Image size 848x848. Posterior pole color fundus photograph. NIDEK AFC-230
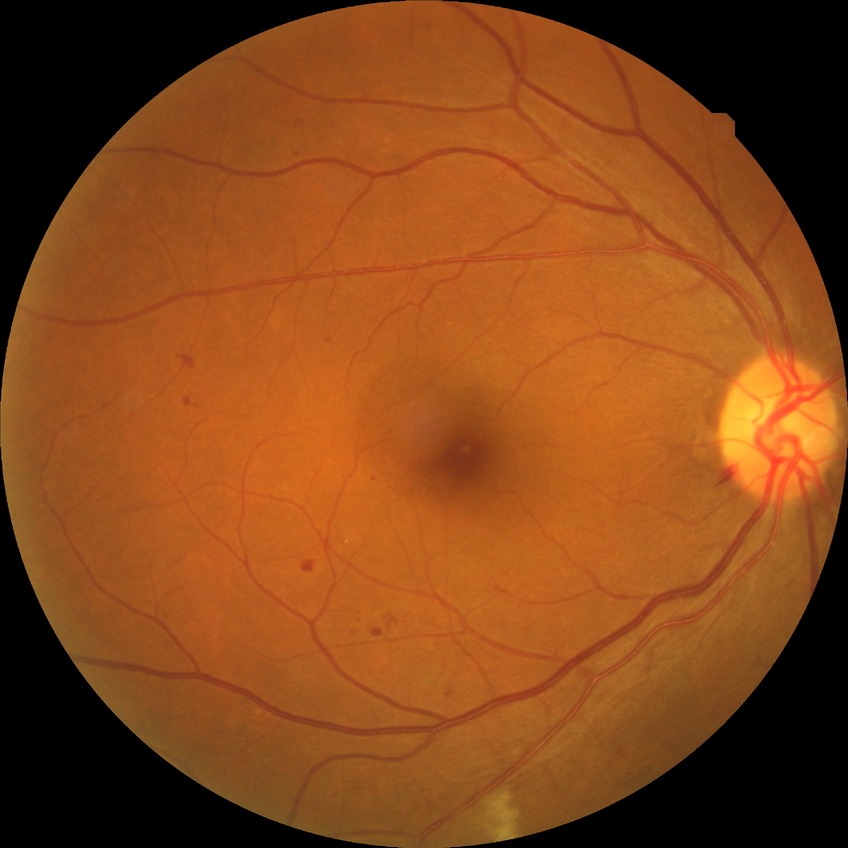

DR stage is SDR.